2346 by 1568 pixels. Fundus photo:
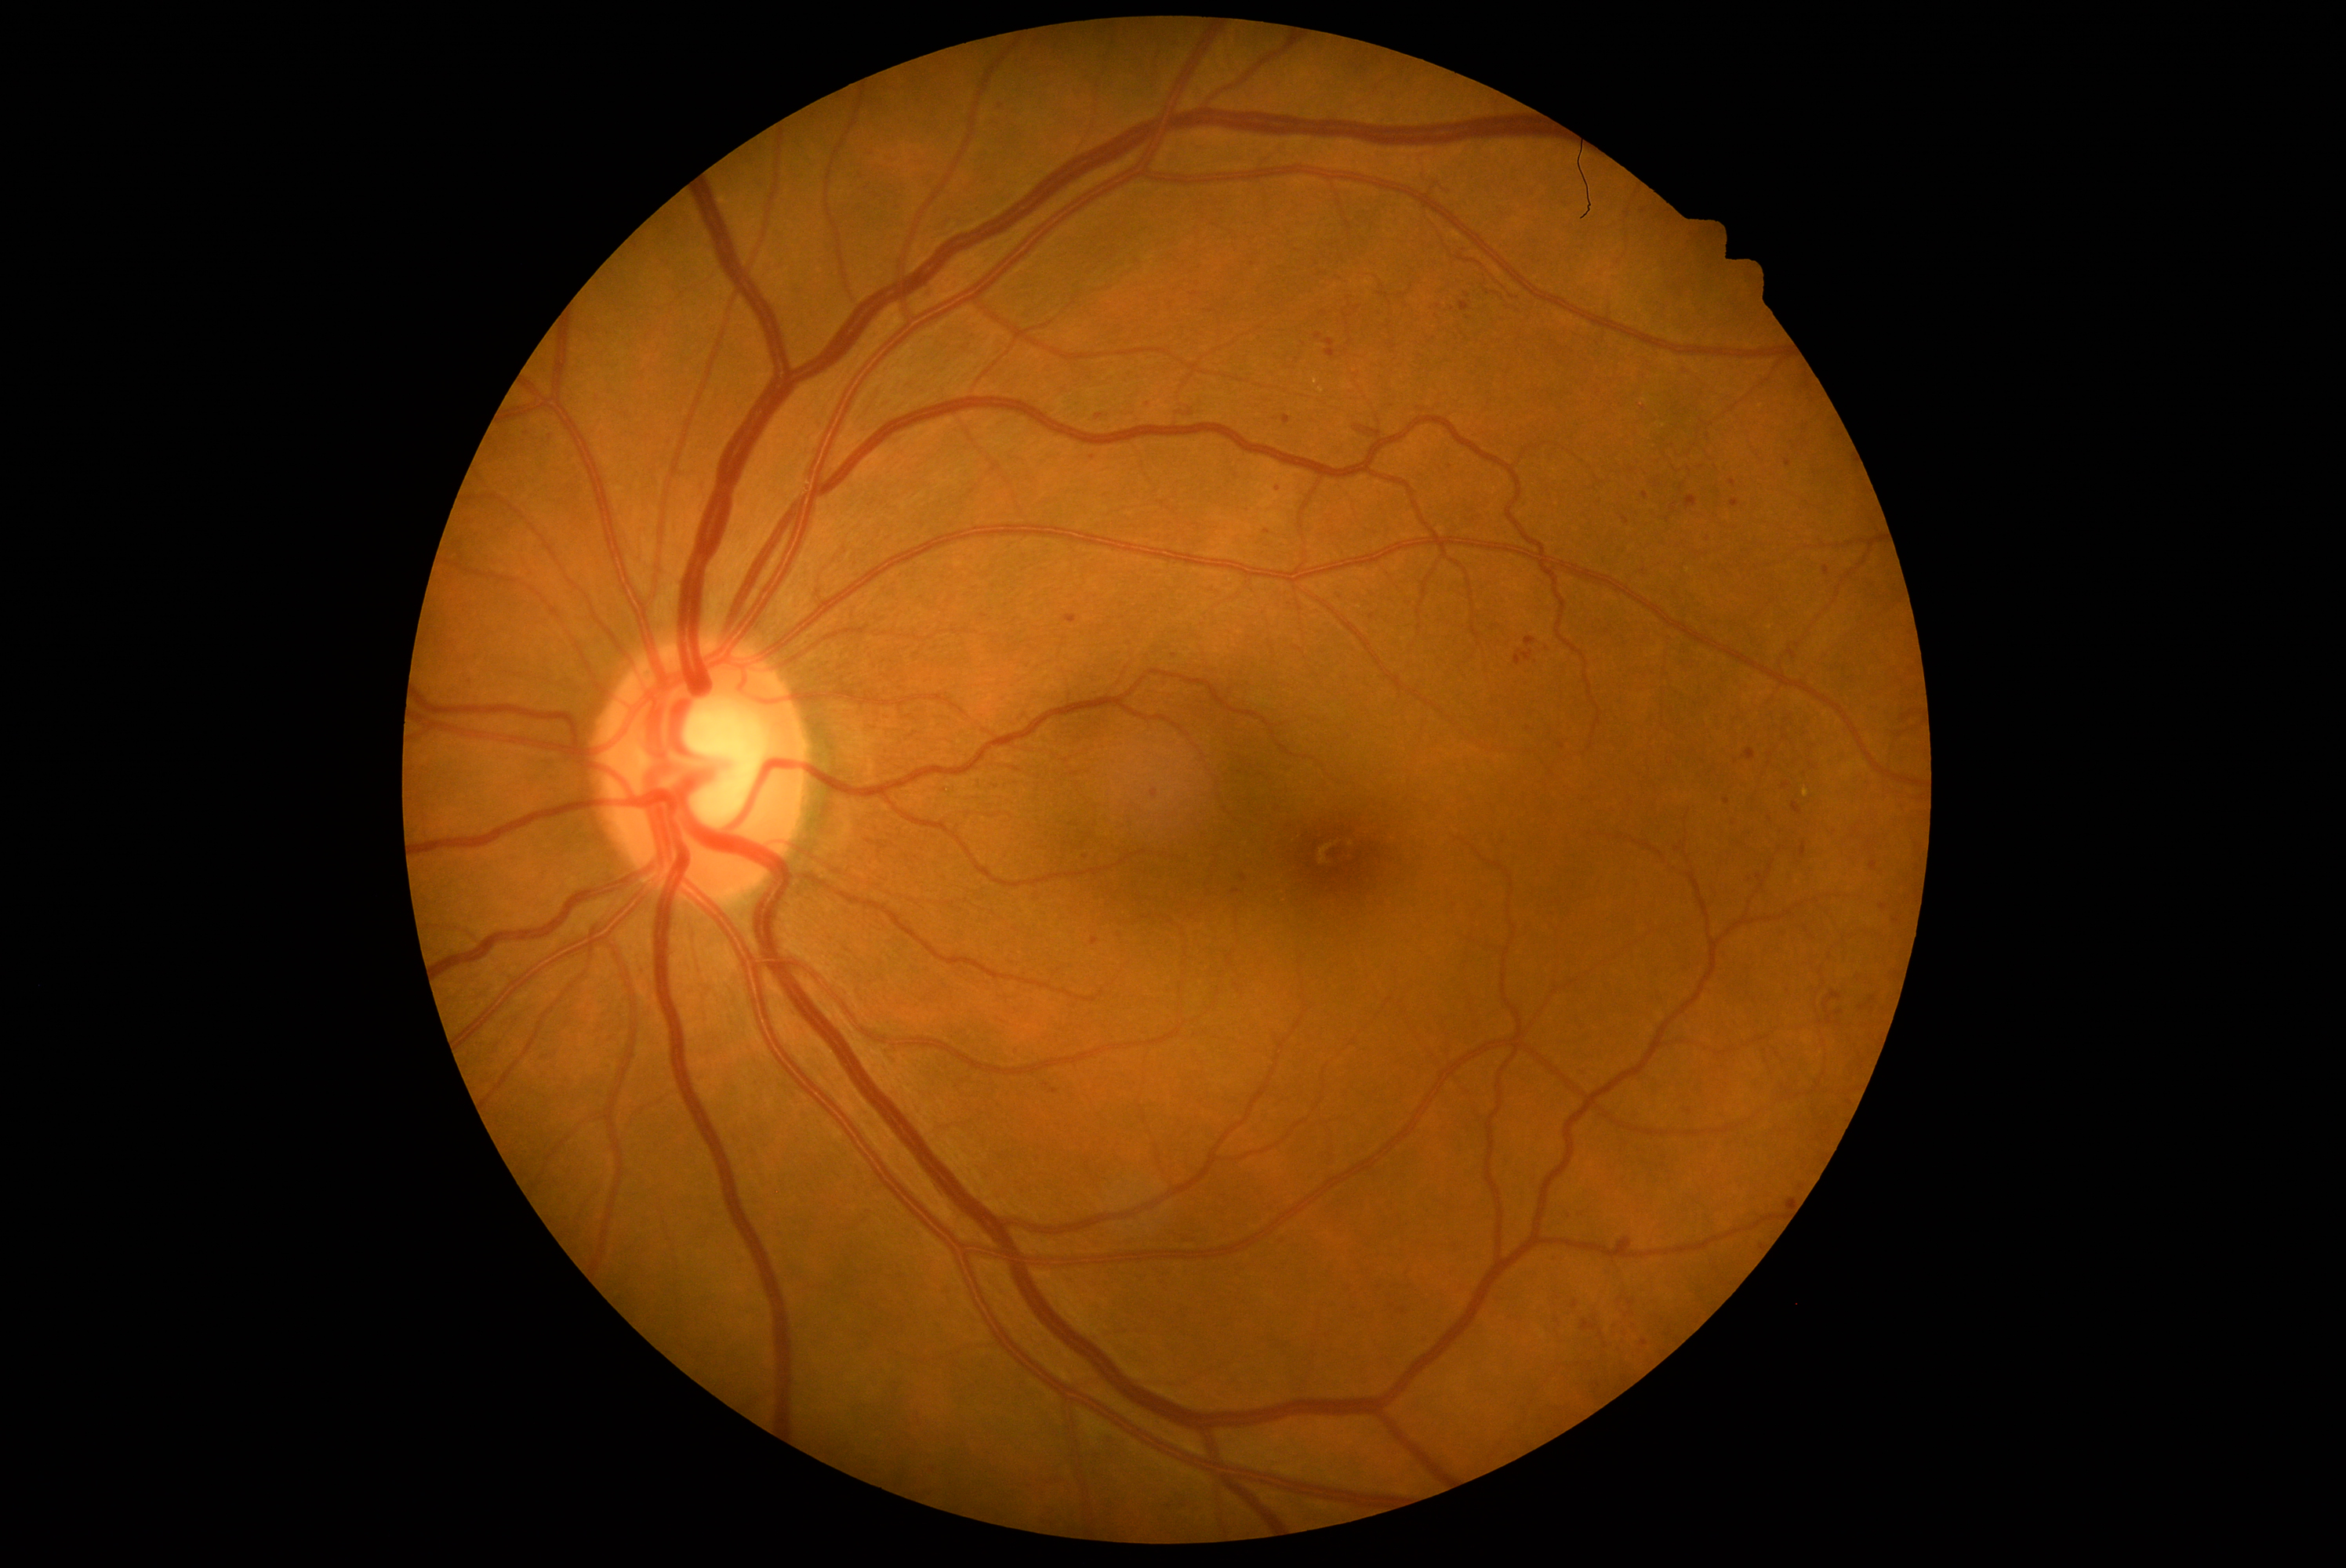 Retinopathy grade is 2 (moderate NPDR)
Representative lesions:
soft exudates: none
hard exudates: (left=1313, top=379, right=1320, bottom=387), (left=1804, top=789, right=1809, bottom=797)
Additional small hard exudates near {"x": 1322, "y": 390}
microaneurysms (partial): (left=1431, top=313, right=1440, bottom=321), (left=1729, top=481, right=1737, bottom=488), (left=1047, top=1426, right=1067, bottom=1440), (left=893, top=200, right=902, bottom=211), (left=1582, top=1321, right=1597, bottom=1332), (left=987, top=118, right=1000, bottom=129), (left=1149, top=1265, right=1175, bottom=1291), (left=1622, top=1301, right=1635, bottom=1318), (left=1851, top=975, right=1864, bottom=985), (left=1705, top=987, right=1715, bottom=996), (left=1792, top=804, right=1803, bottom=815), (left=1398, top=1308, right=1406, bottom=1315)
Additional small microaneurysms near {"x": 1452, "y": 309}, {"x": 637, "y": 249}, {"x": 1324, "y": 313}, {"x": 1601, "y": 1334}, {"x": 1625, "y": 521}, {"x": 1631, "y": 470}, {"x": 1085, "y": 857}, {"x": 1708, "y": 540}
hemorrhages: none